Pediatric wide-field fundus photograph. 1240x1240. Phoenix ICON, 100° FOV — 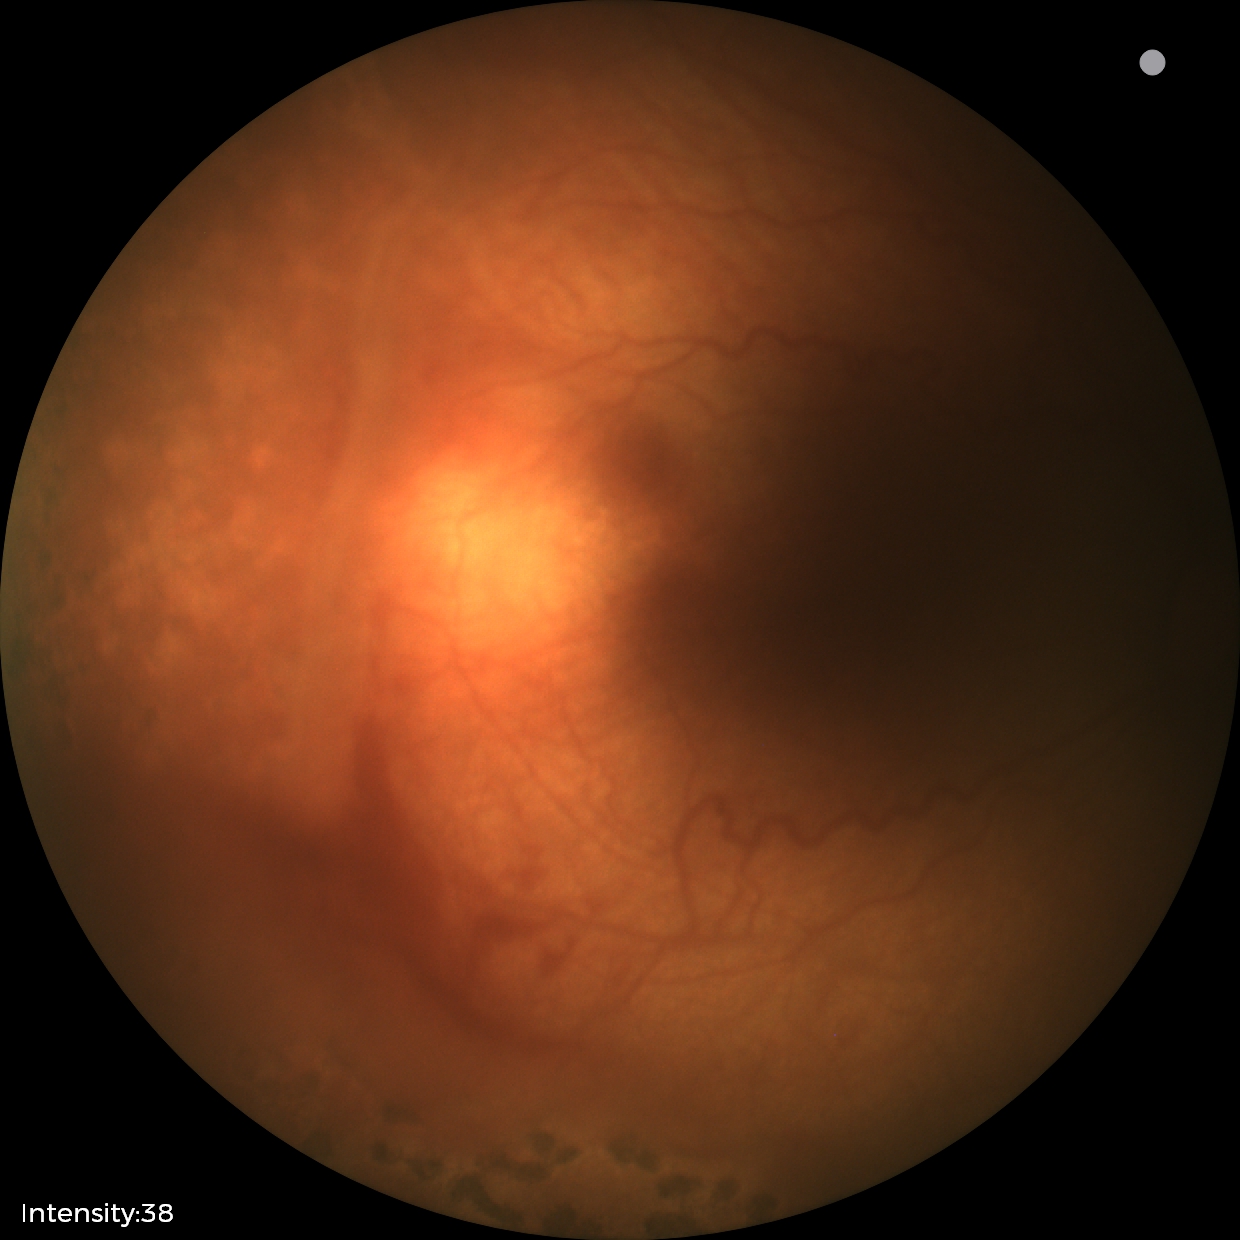
Assessment: status post ROP — retinal appearance after treated retinopathy of prematurity.